45° FOV, color fundus photograph.
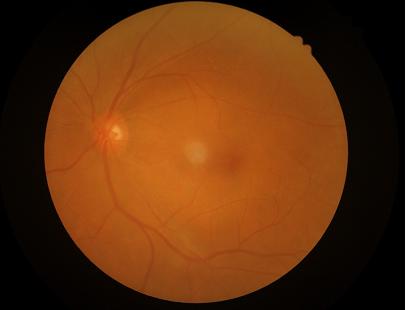

clarity: out of focus, structures indistinct
overall_quality: inadequate for clinical interpretation
illumination: uniform, no color cast